848 by 848 pixels, camera: NIDEK AFC-230.
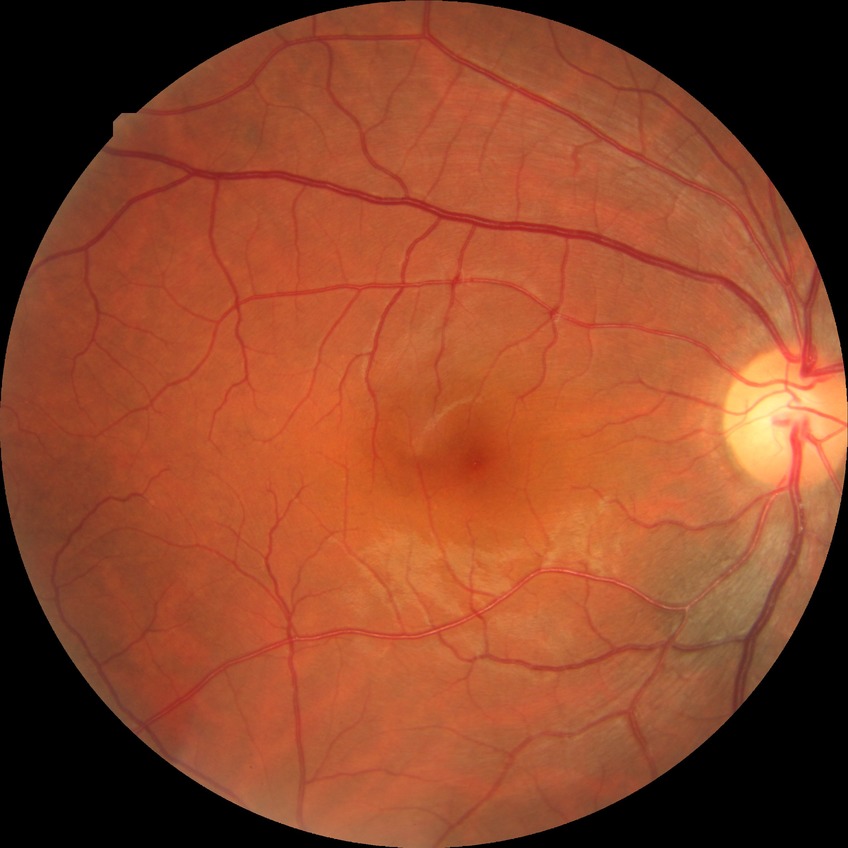
Modified Davis grading is no diabetic retinopathy.